DR severity per modified Davis staging. Fundus photo
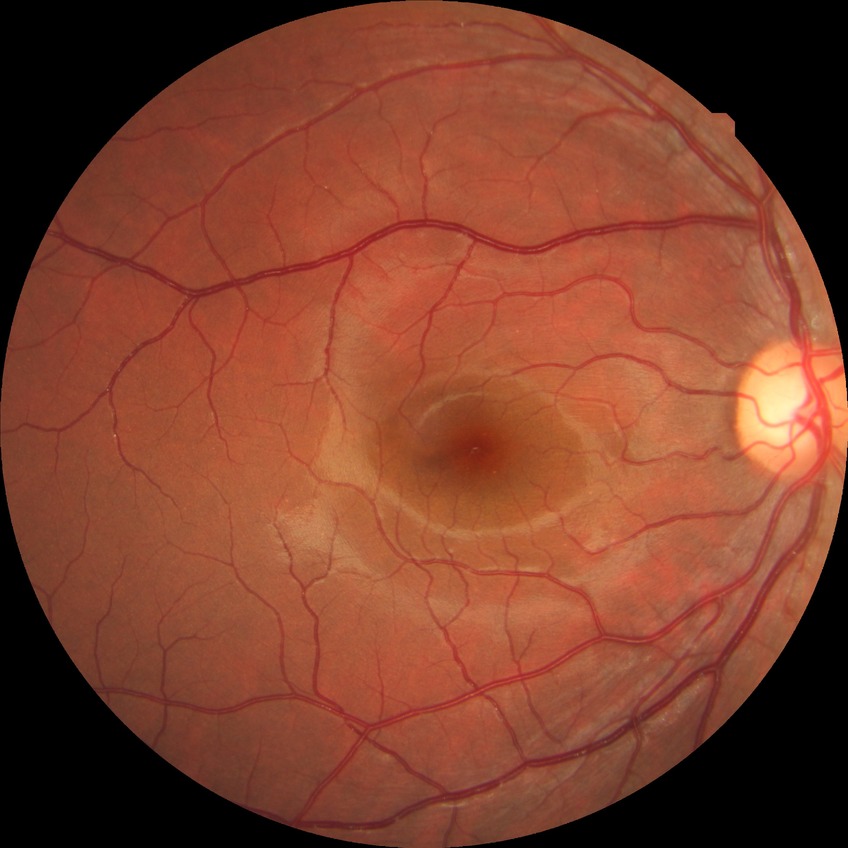 Diabetic retinopathy (DR) is no diabetic retinopathy (NDR).